Camera: NIDEK AFC-230; 45-degree field of view
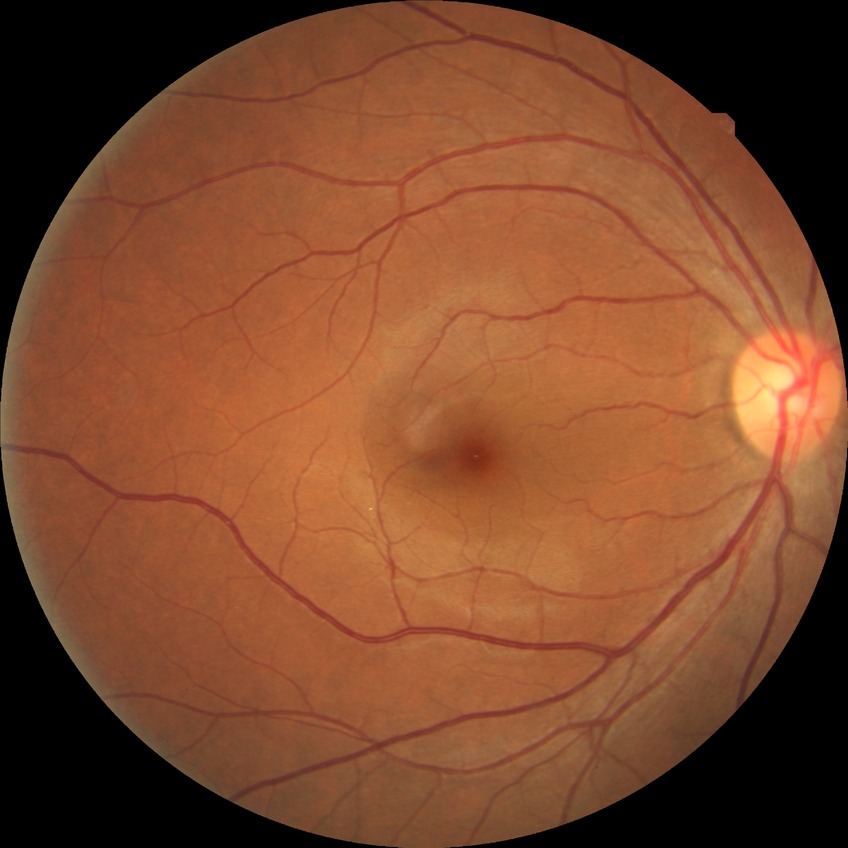 DR=NDR.